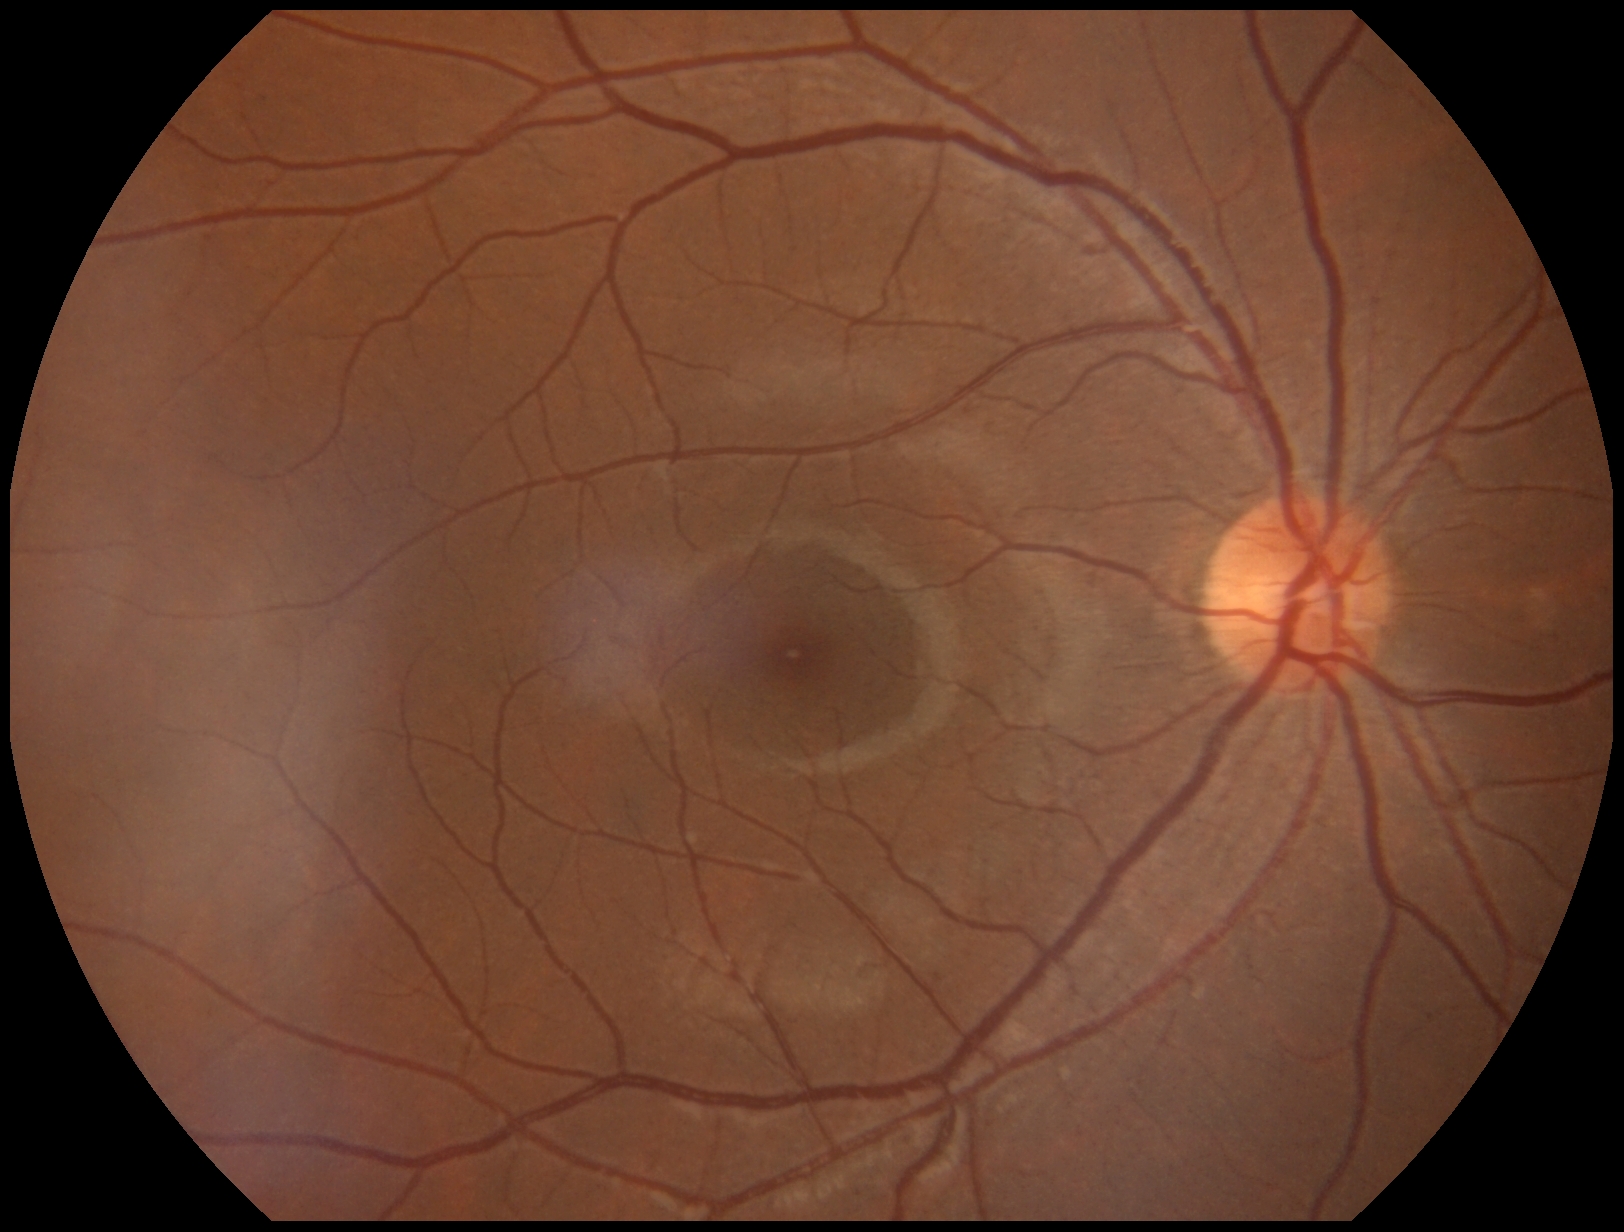 • retinopathy — no apparent retinopathy (grade 0)